Acquired on the Natus RetCam Envision · wide-field fundus image from infant ROP screening.
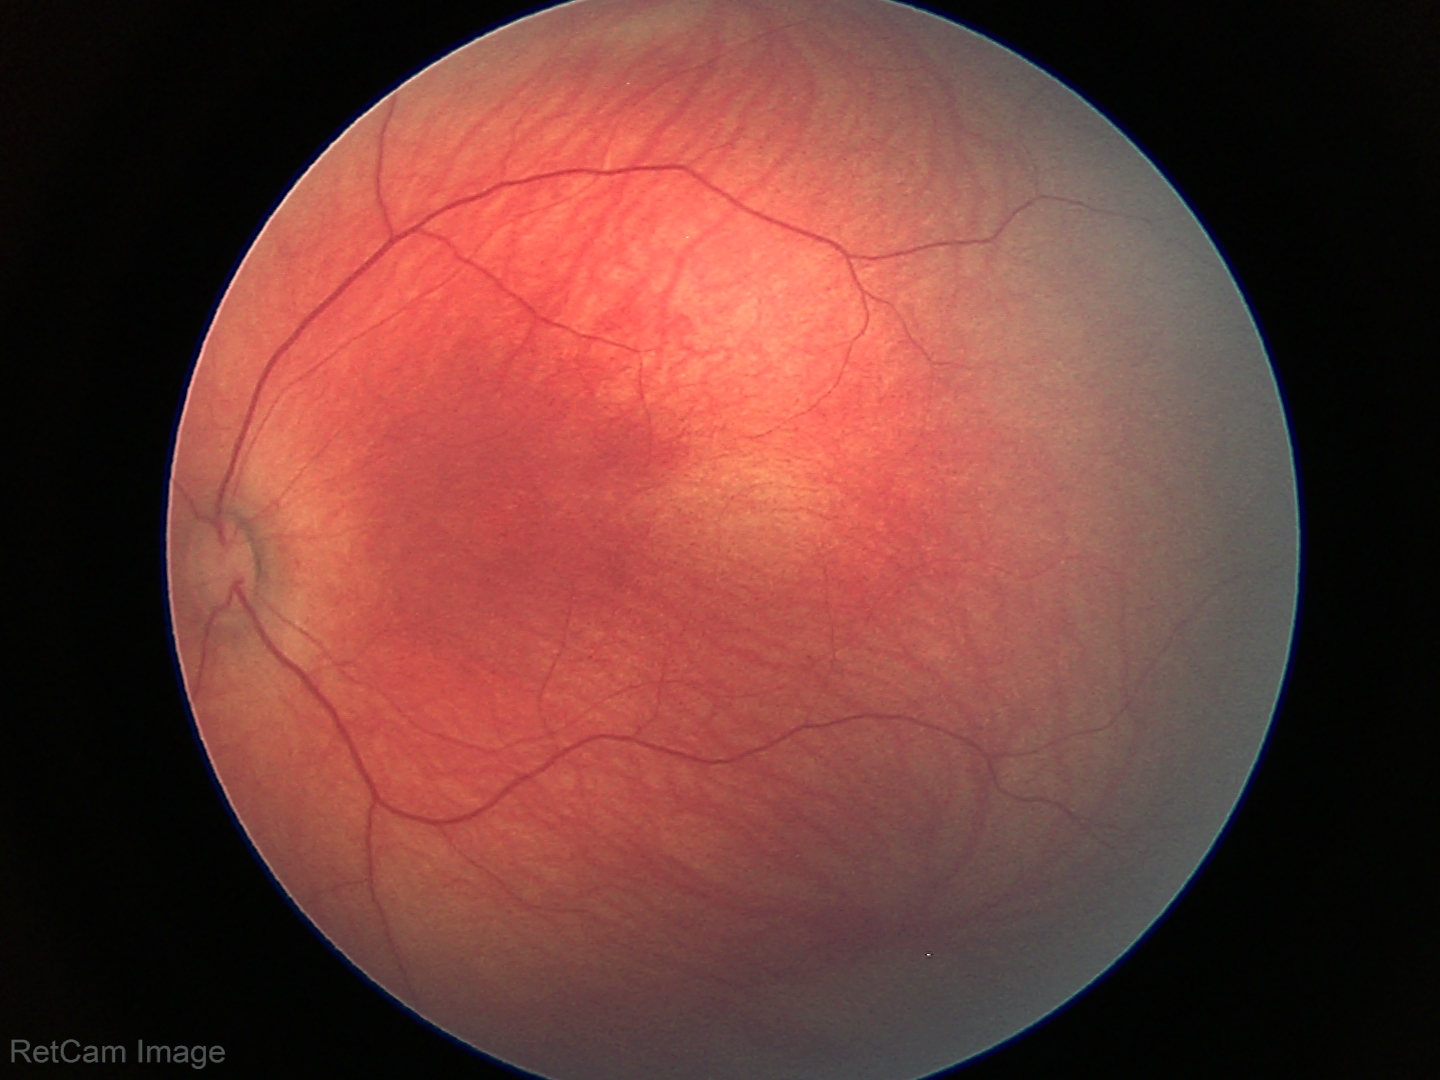

Screening examination diagnosed as physiological.